Color fundus photograph · FOV: 45 degrees · image size 2048x1536 — 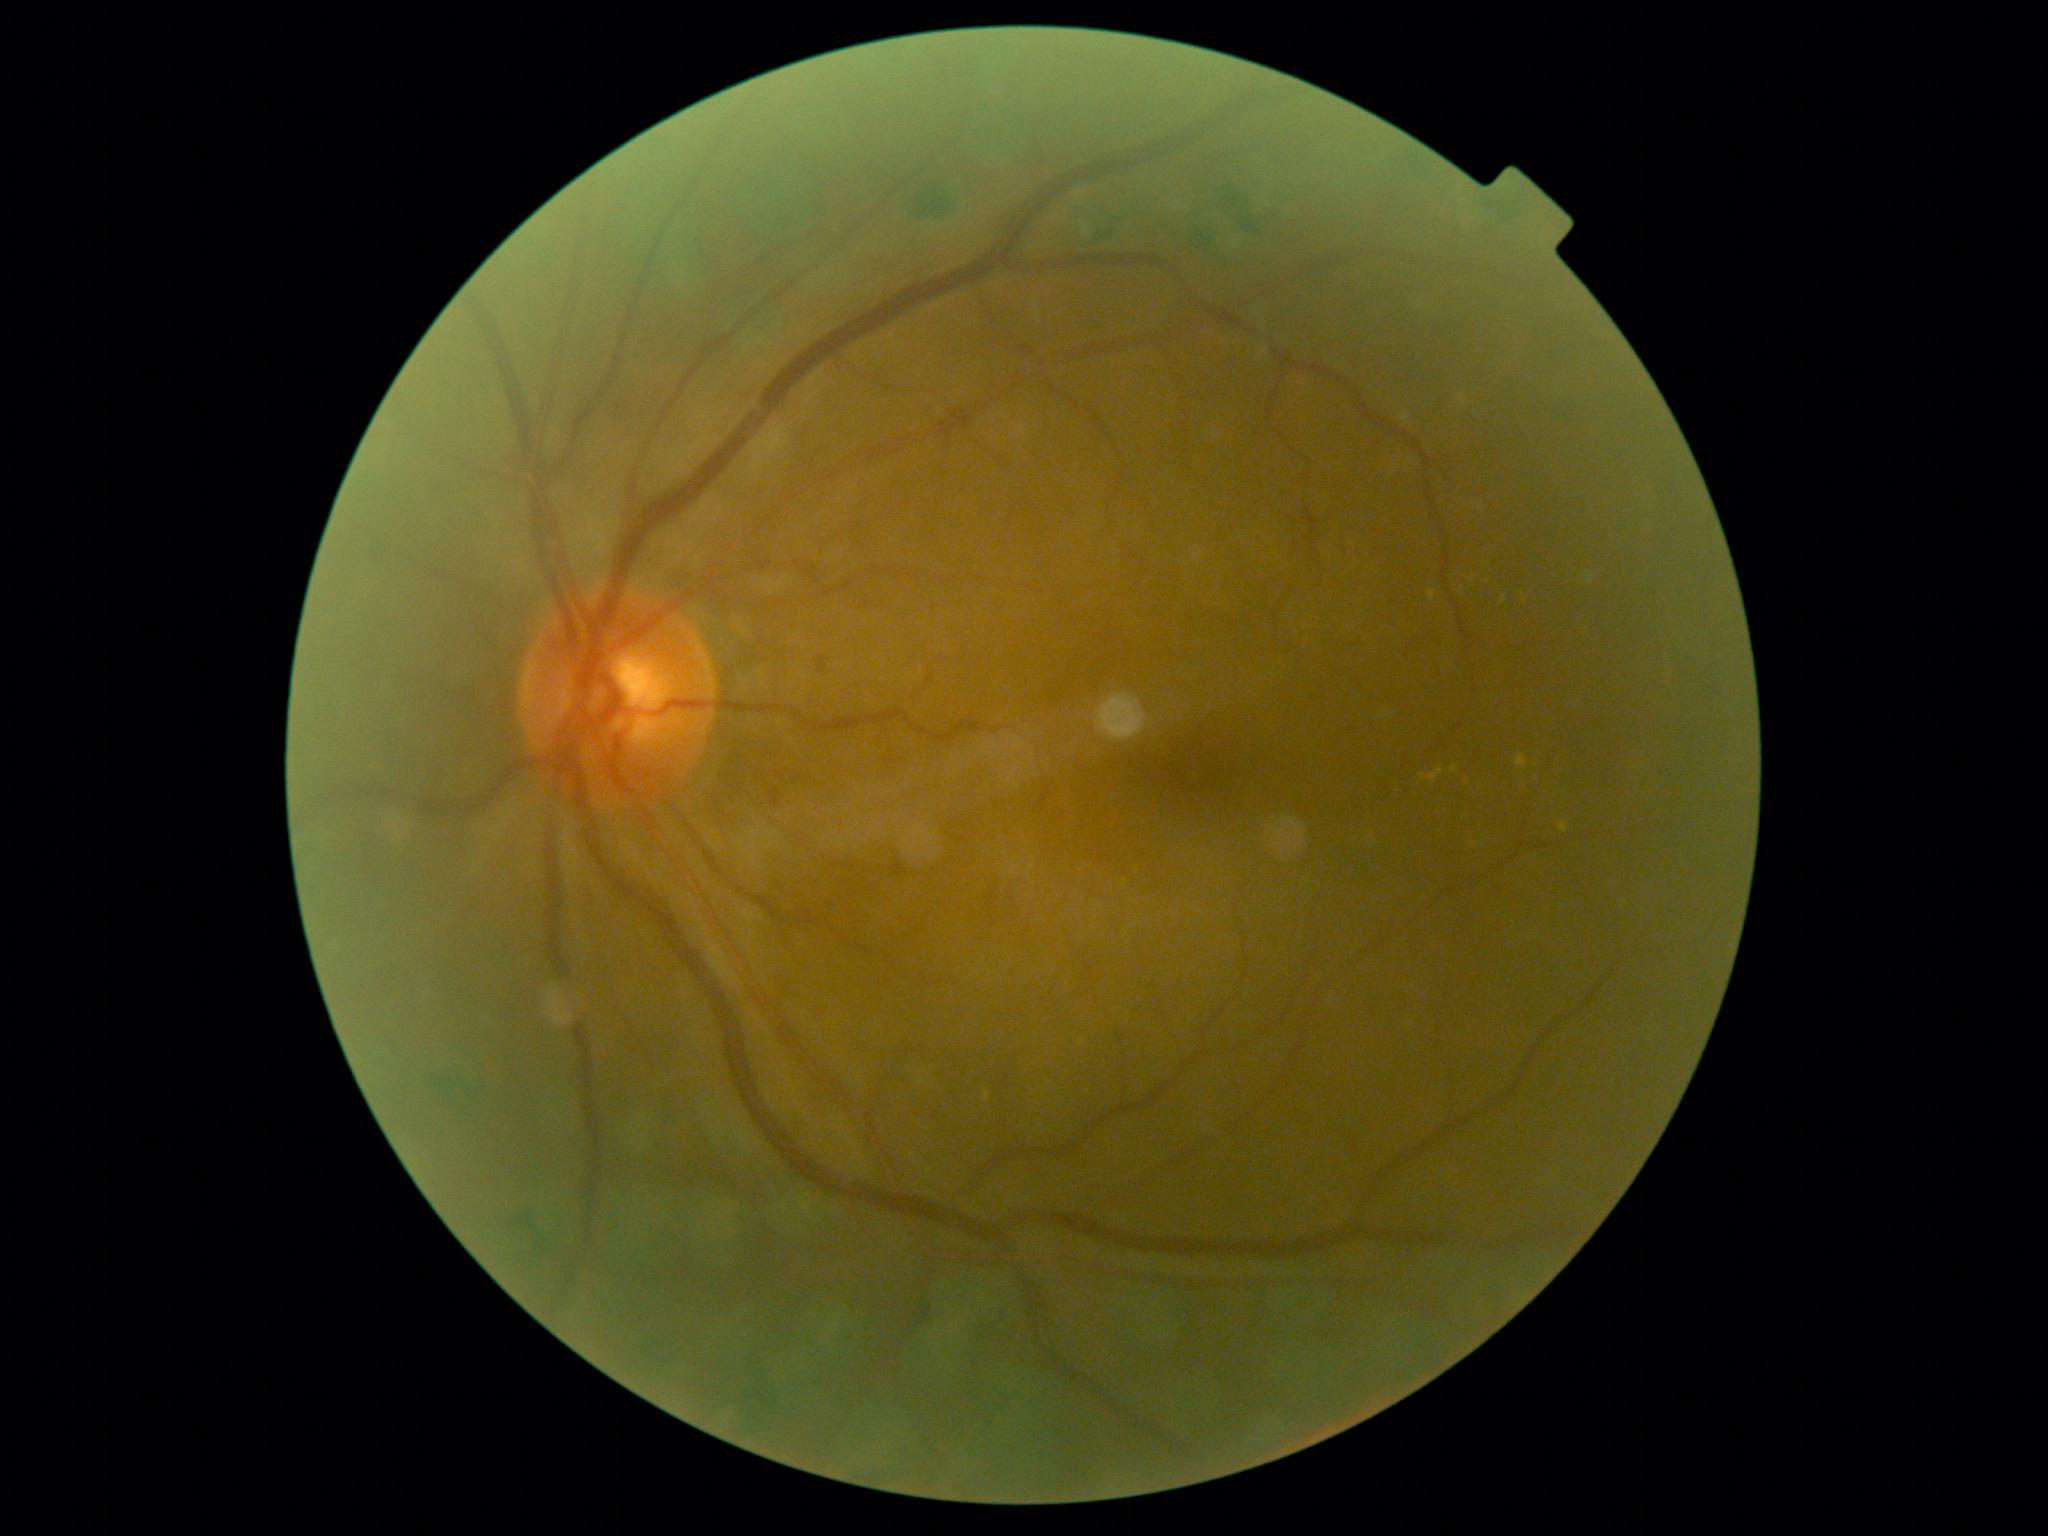
Diabetic retinopathy: 2.